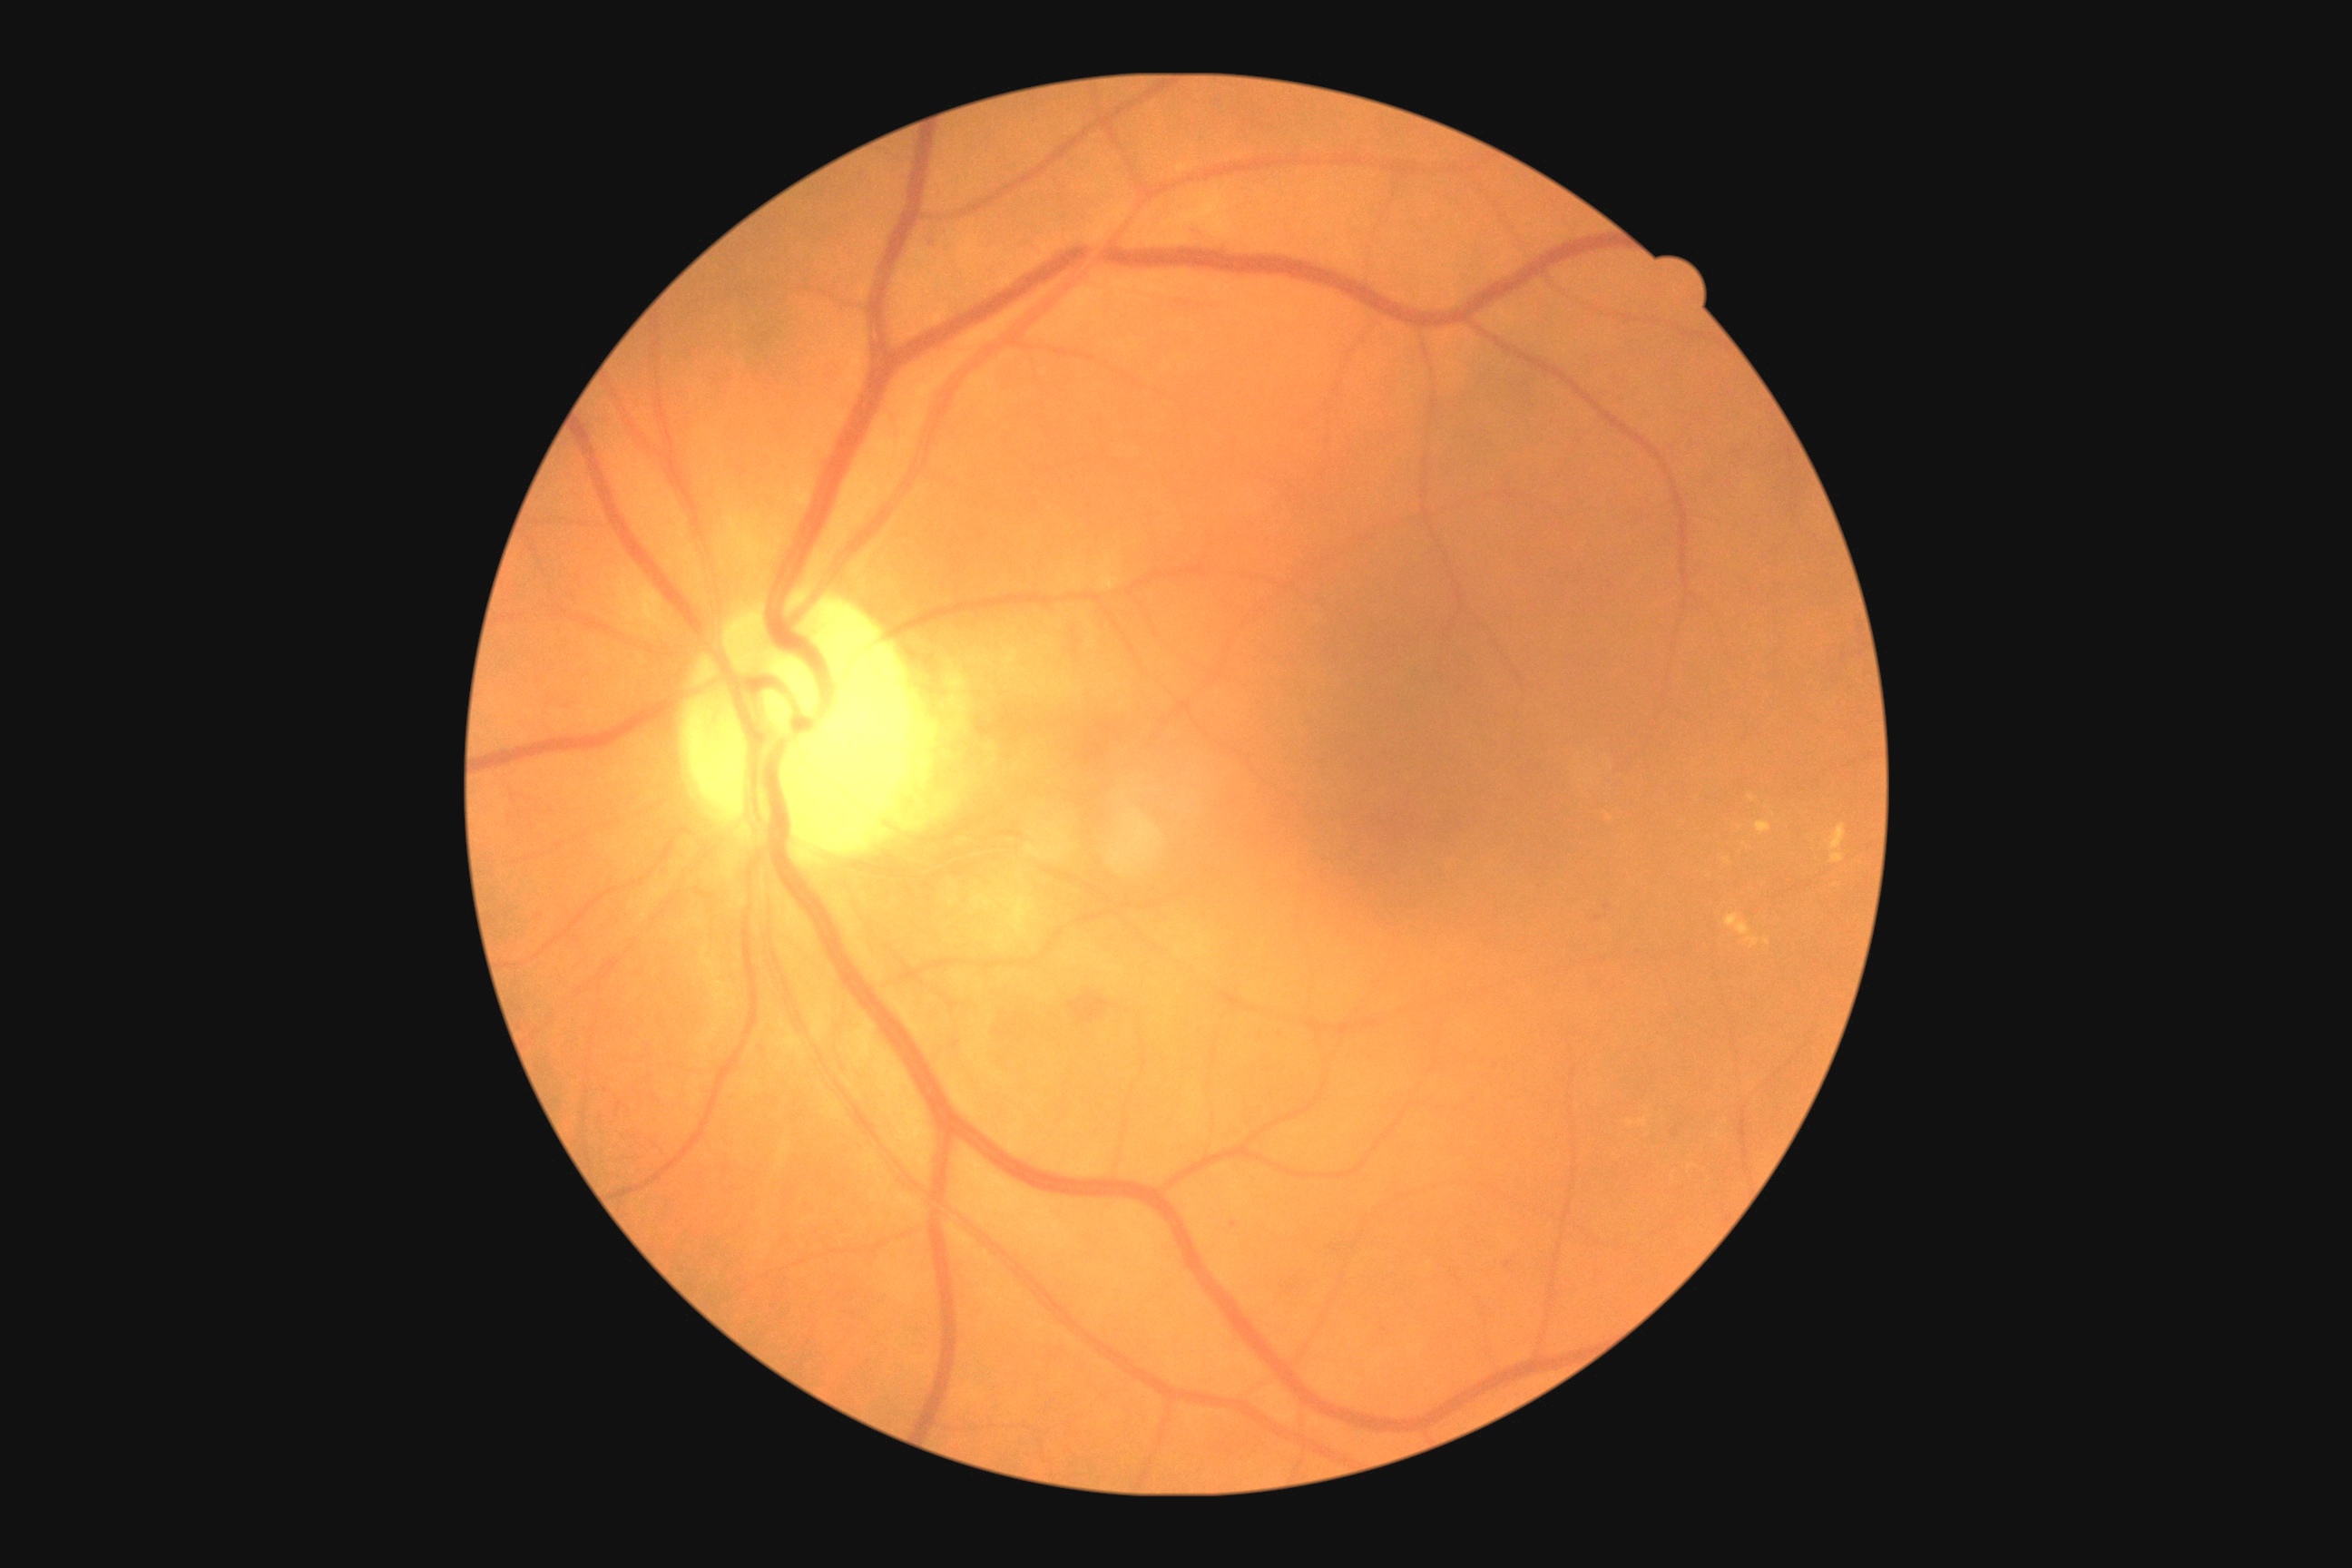

The retinopathy is classified as non-proliferative diabetic retinopathy. DR grade is moderate NPDR (2) — more than just microaneurysms but less than severe NPDR.